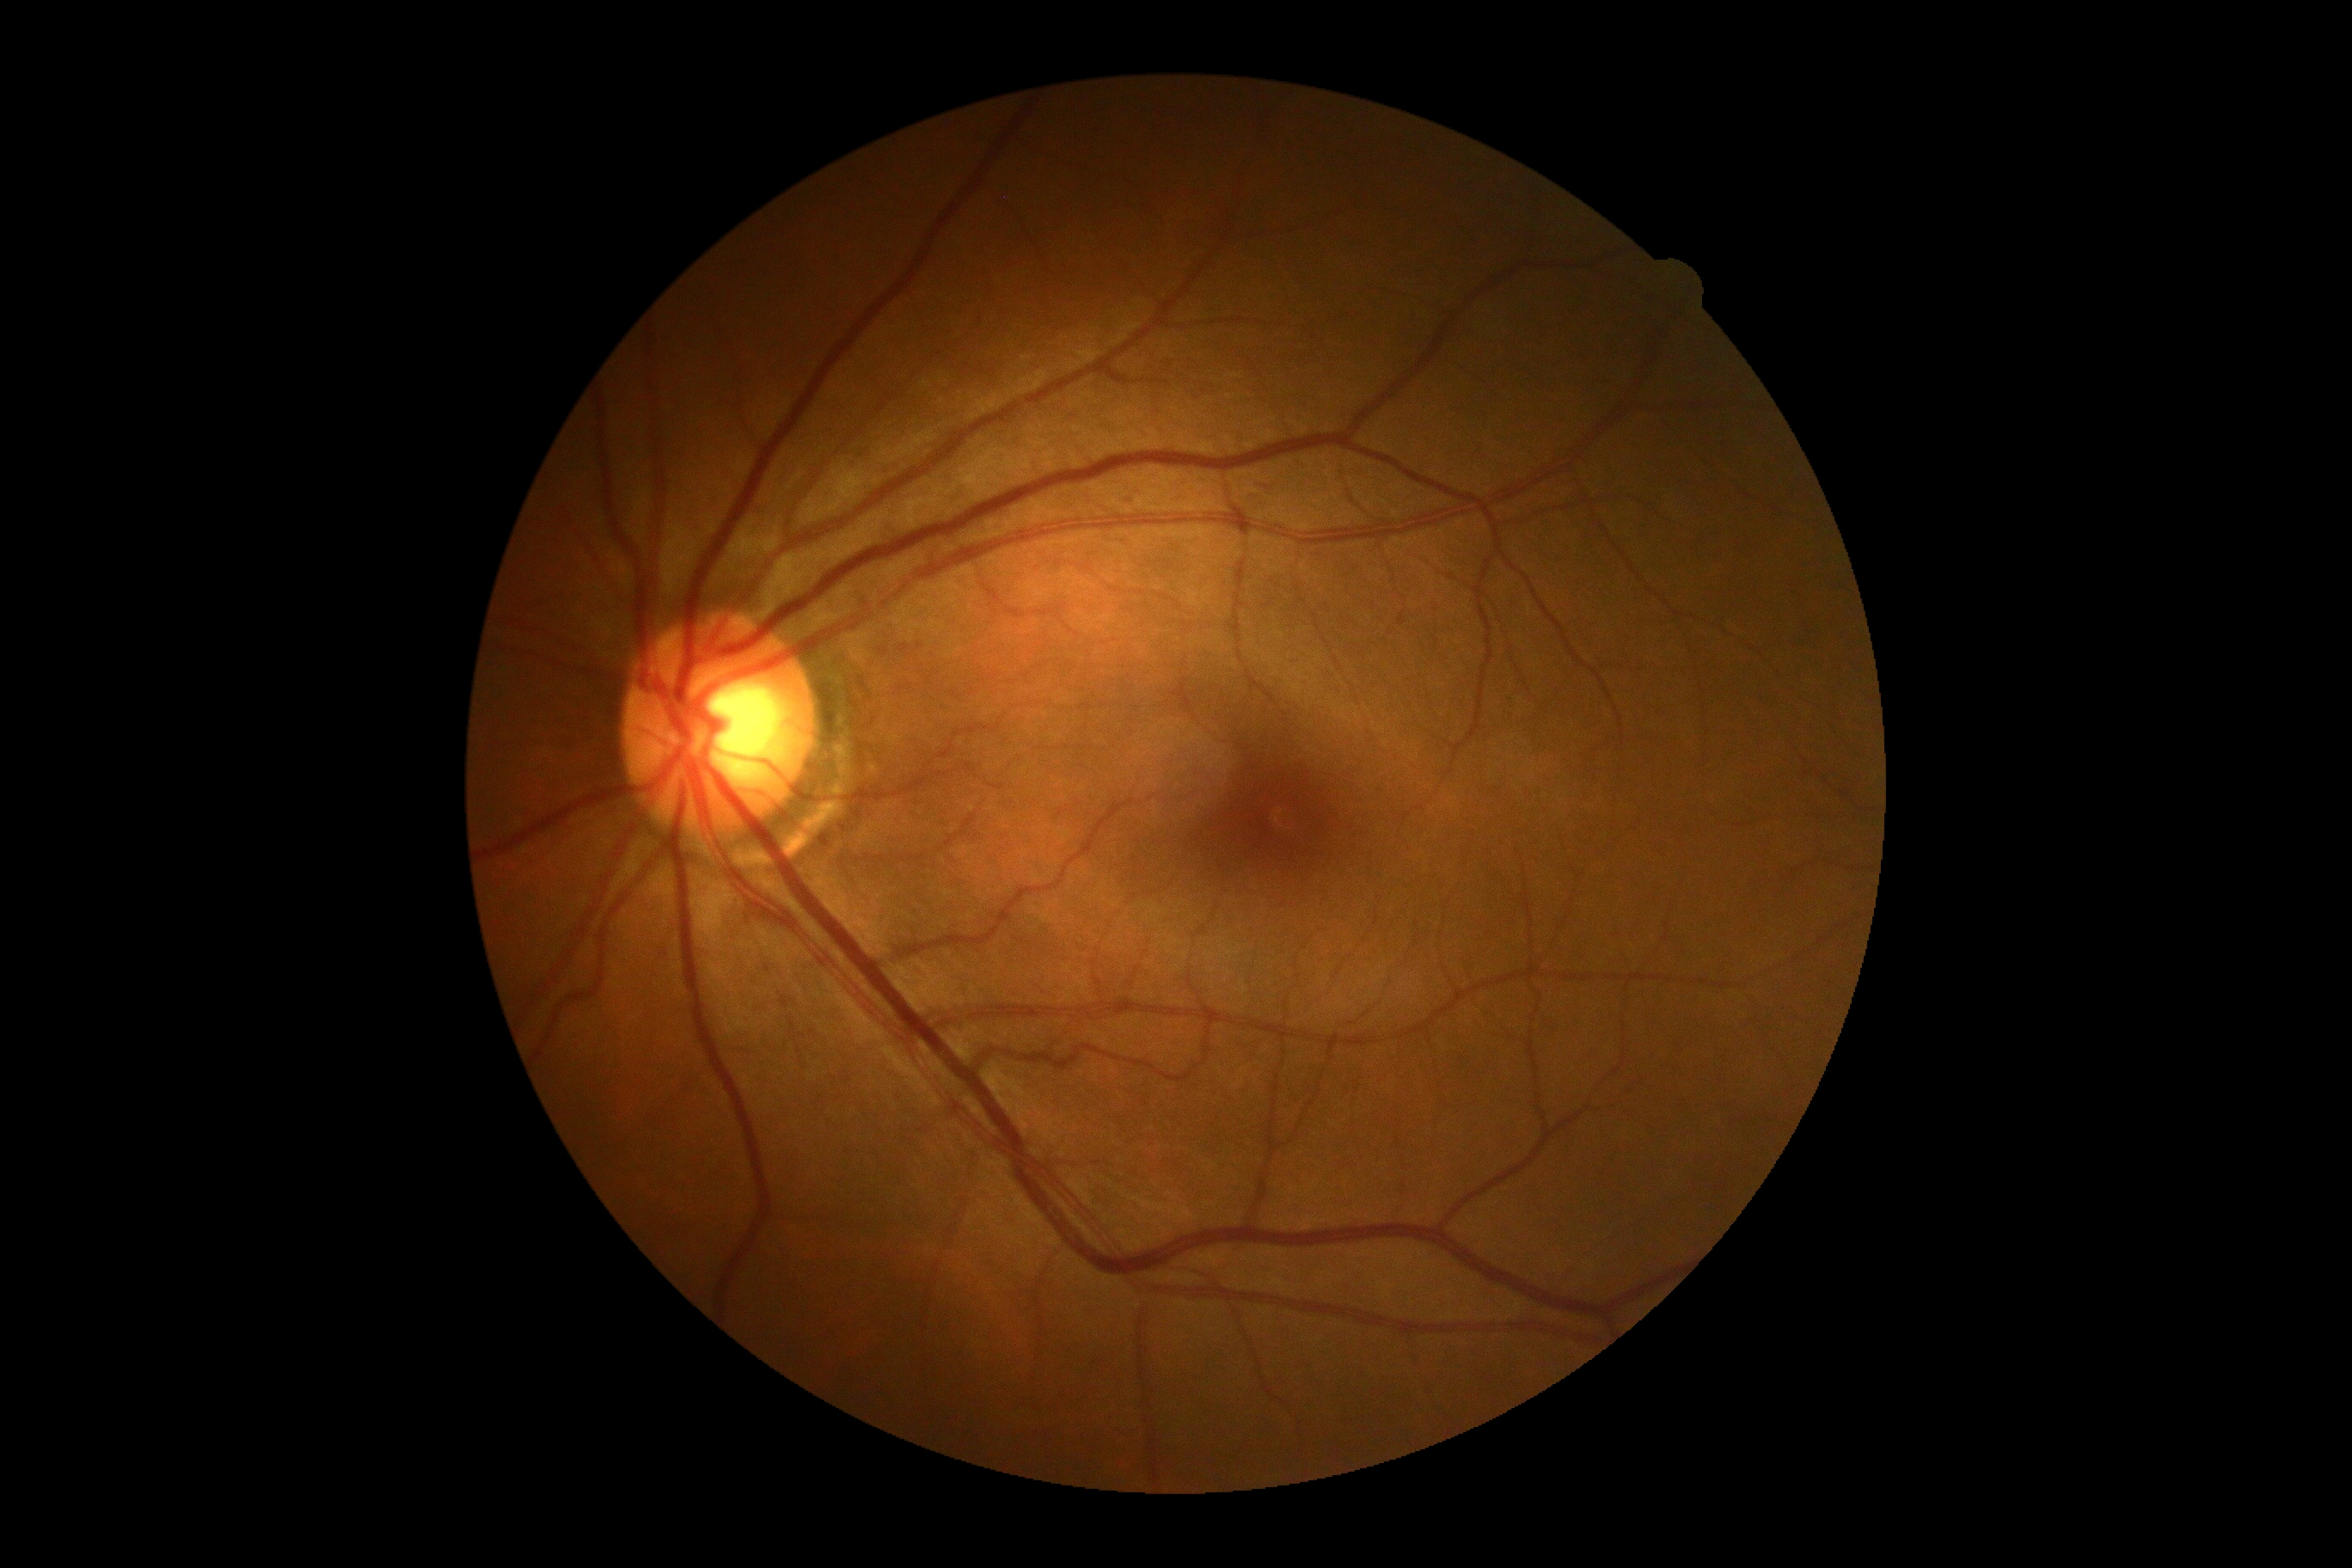
DR: no apparent retinopathy (grade 0) — no visible signs of diabetic retinopathy.